Graded on the modified Davis scale:
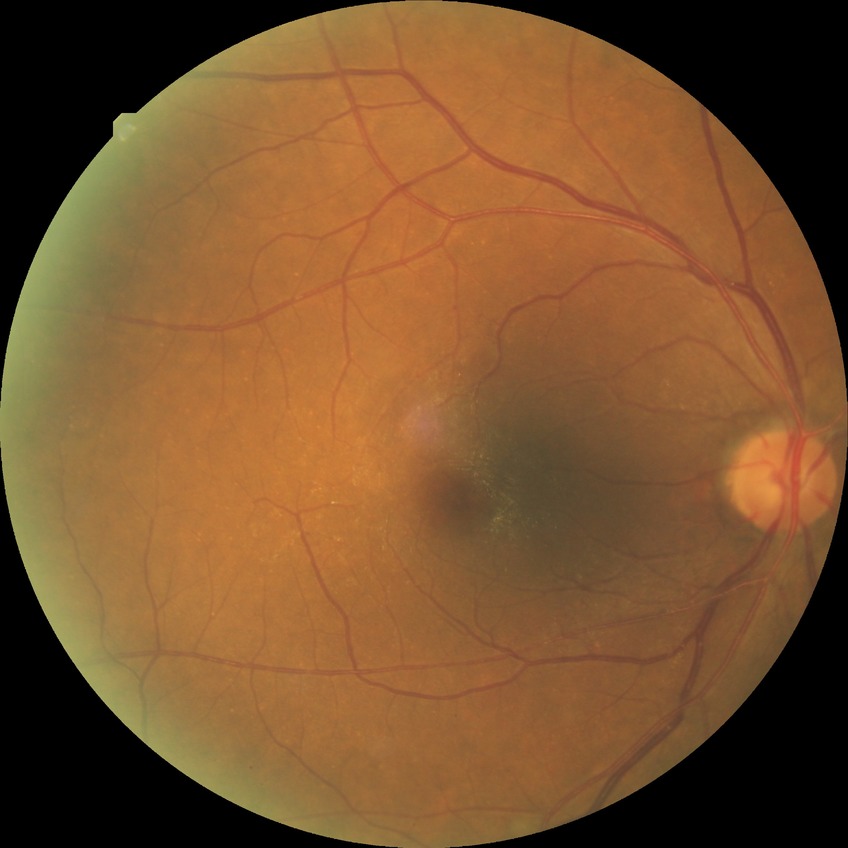

Modified Davis classification: simple diabetic retinopathy.